RetCam wide-field infant fundus image
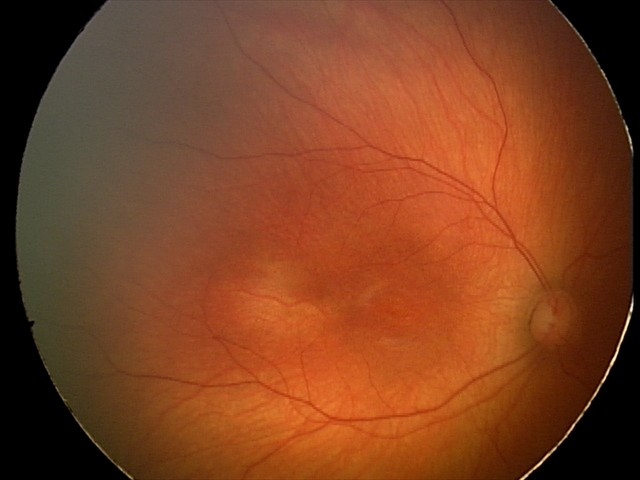

Screening examination diagnosed as physiological.